Wide-field fundus photograph of an infant: 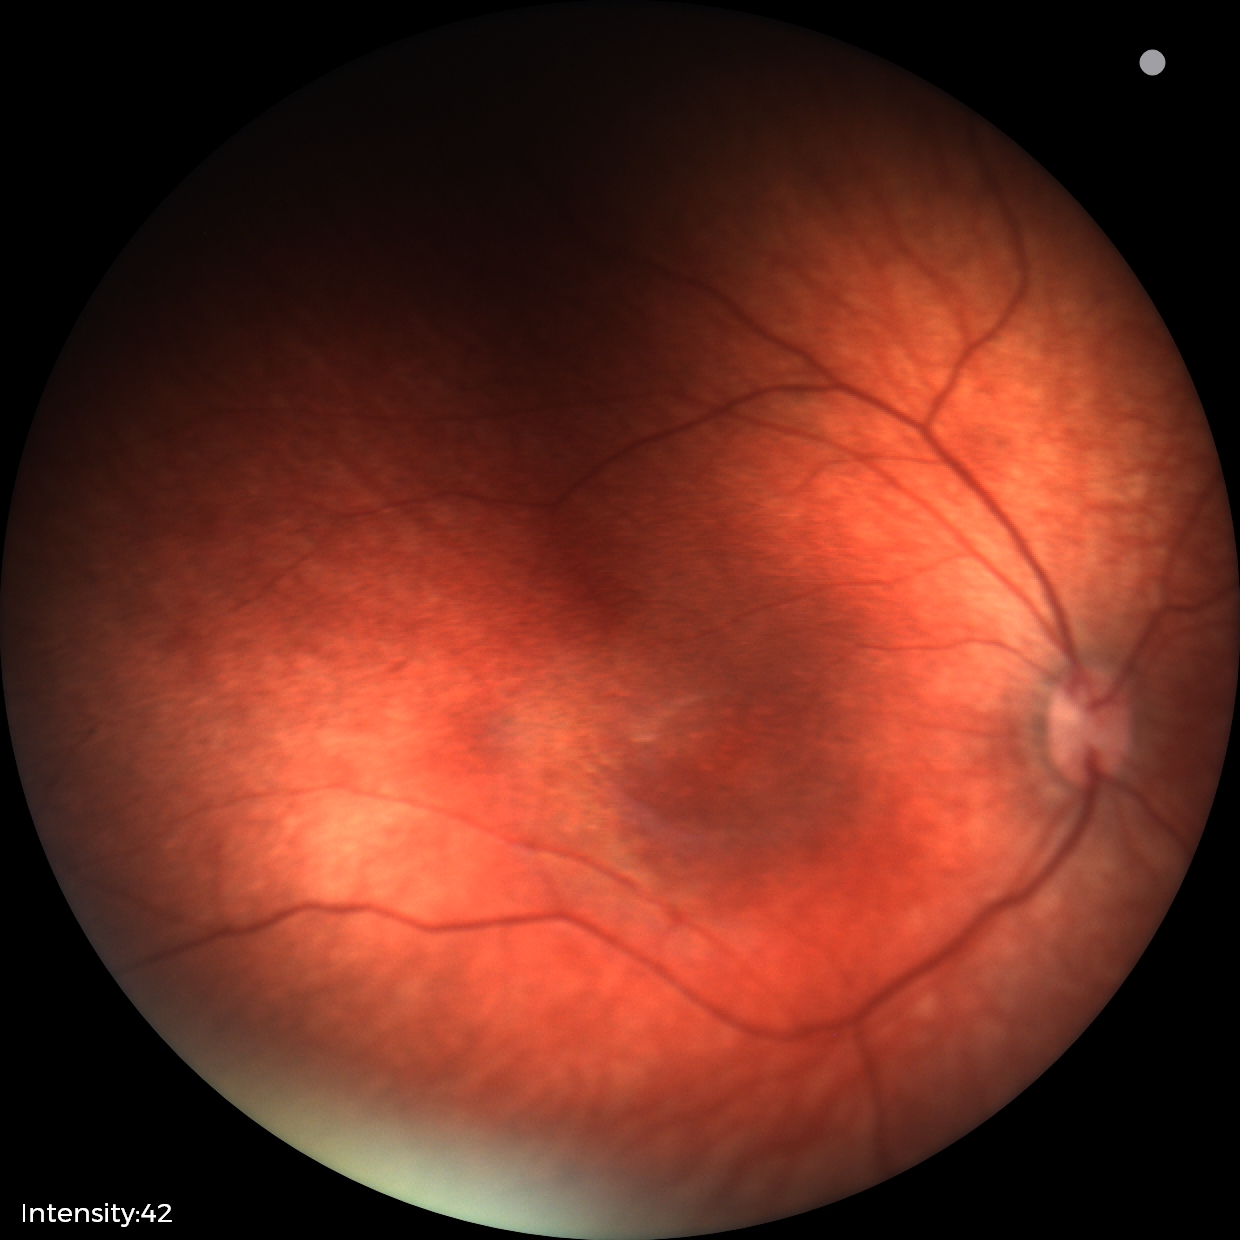
Physiological retinal appearance for postconceptual age.